Modified Davis classification — 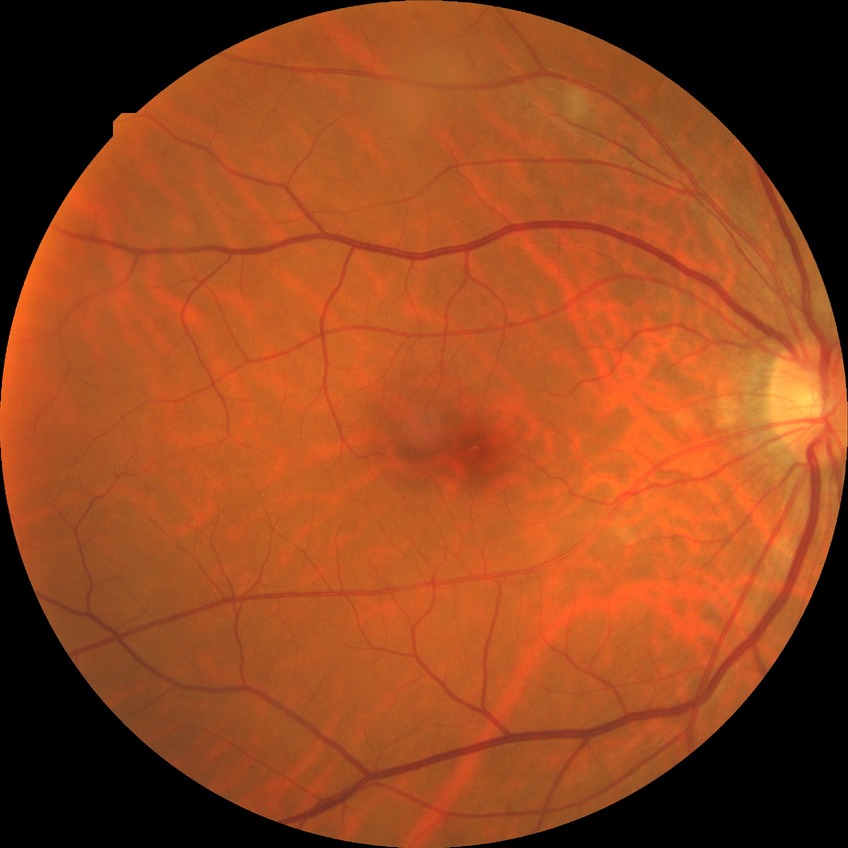

Retinopathy grade is no diabetic retinopathy.